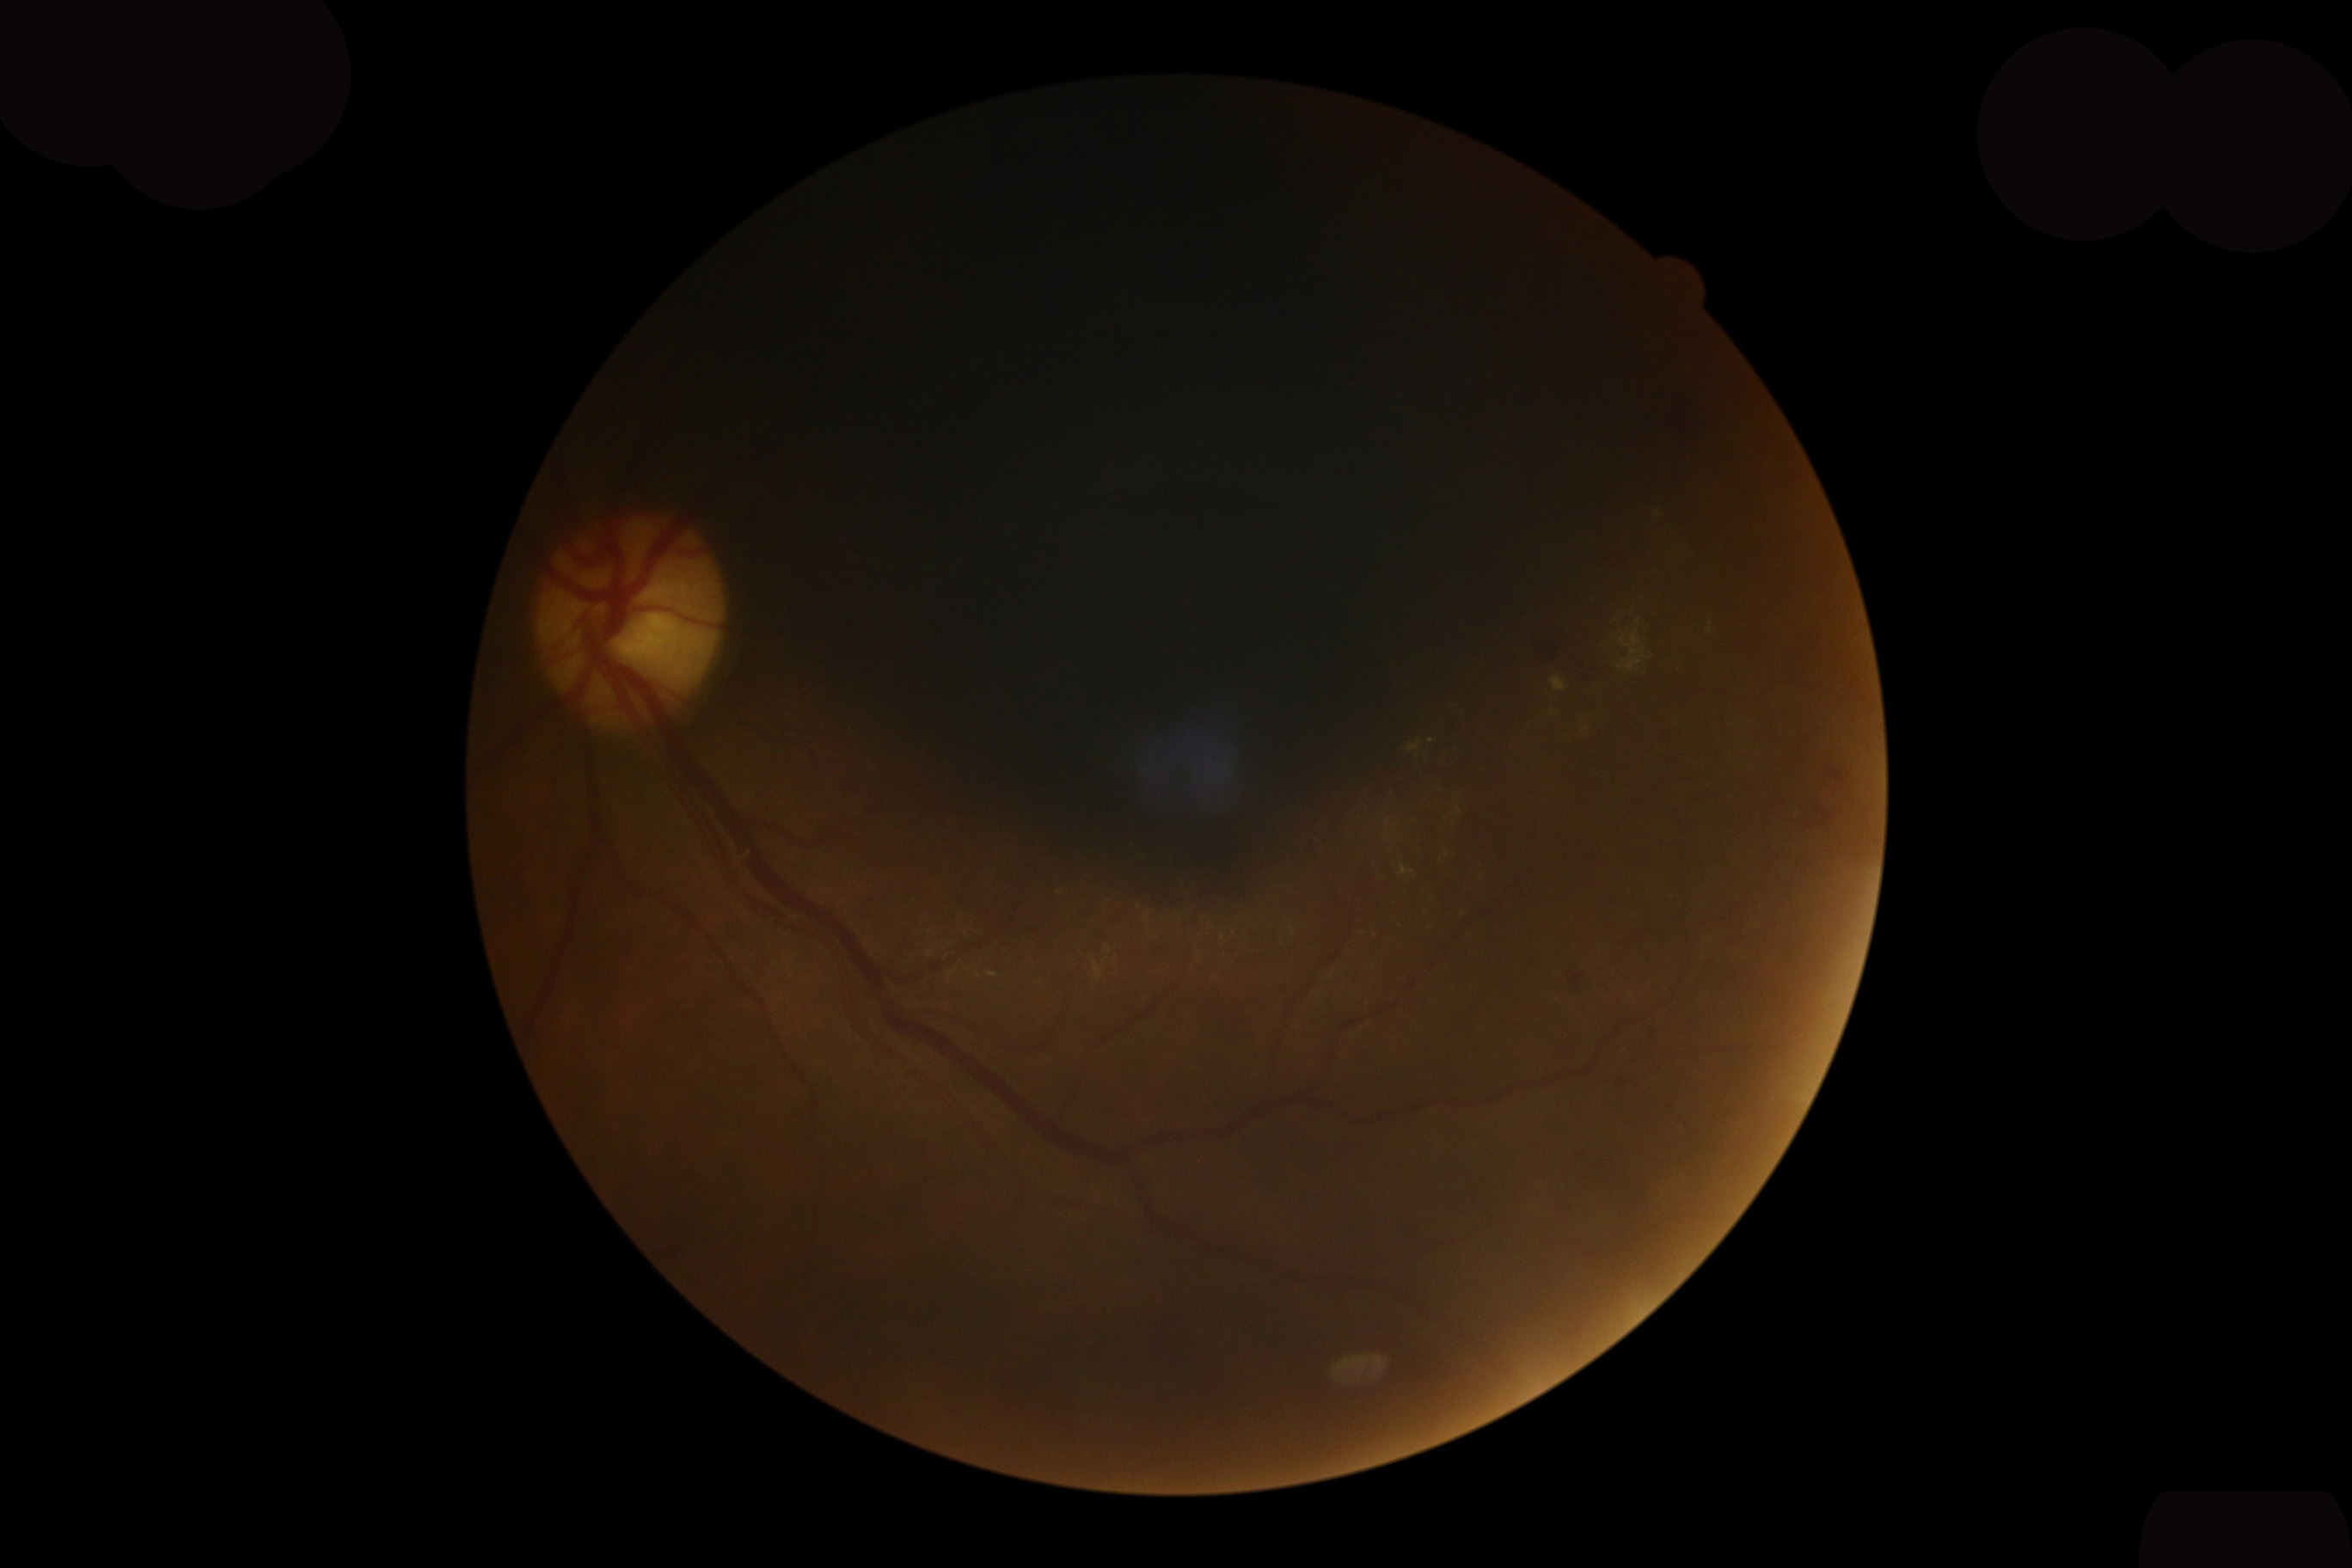 Retinopathy grade: moderate non-proliferative diabetic retinopathy (2).